Fundus photo. Centered on the macula — 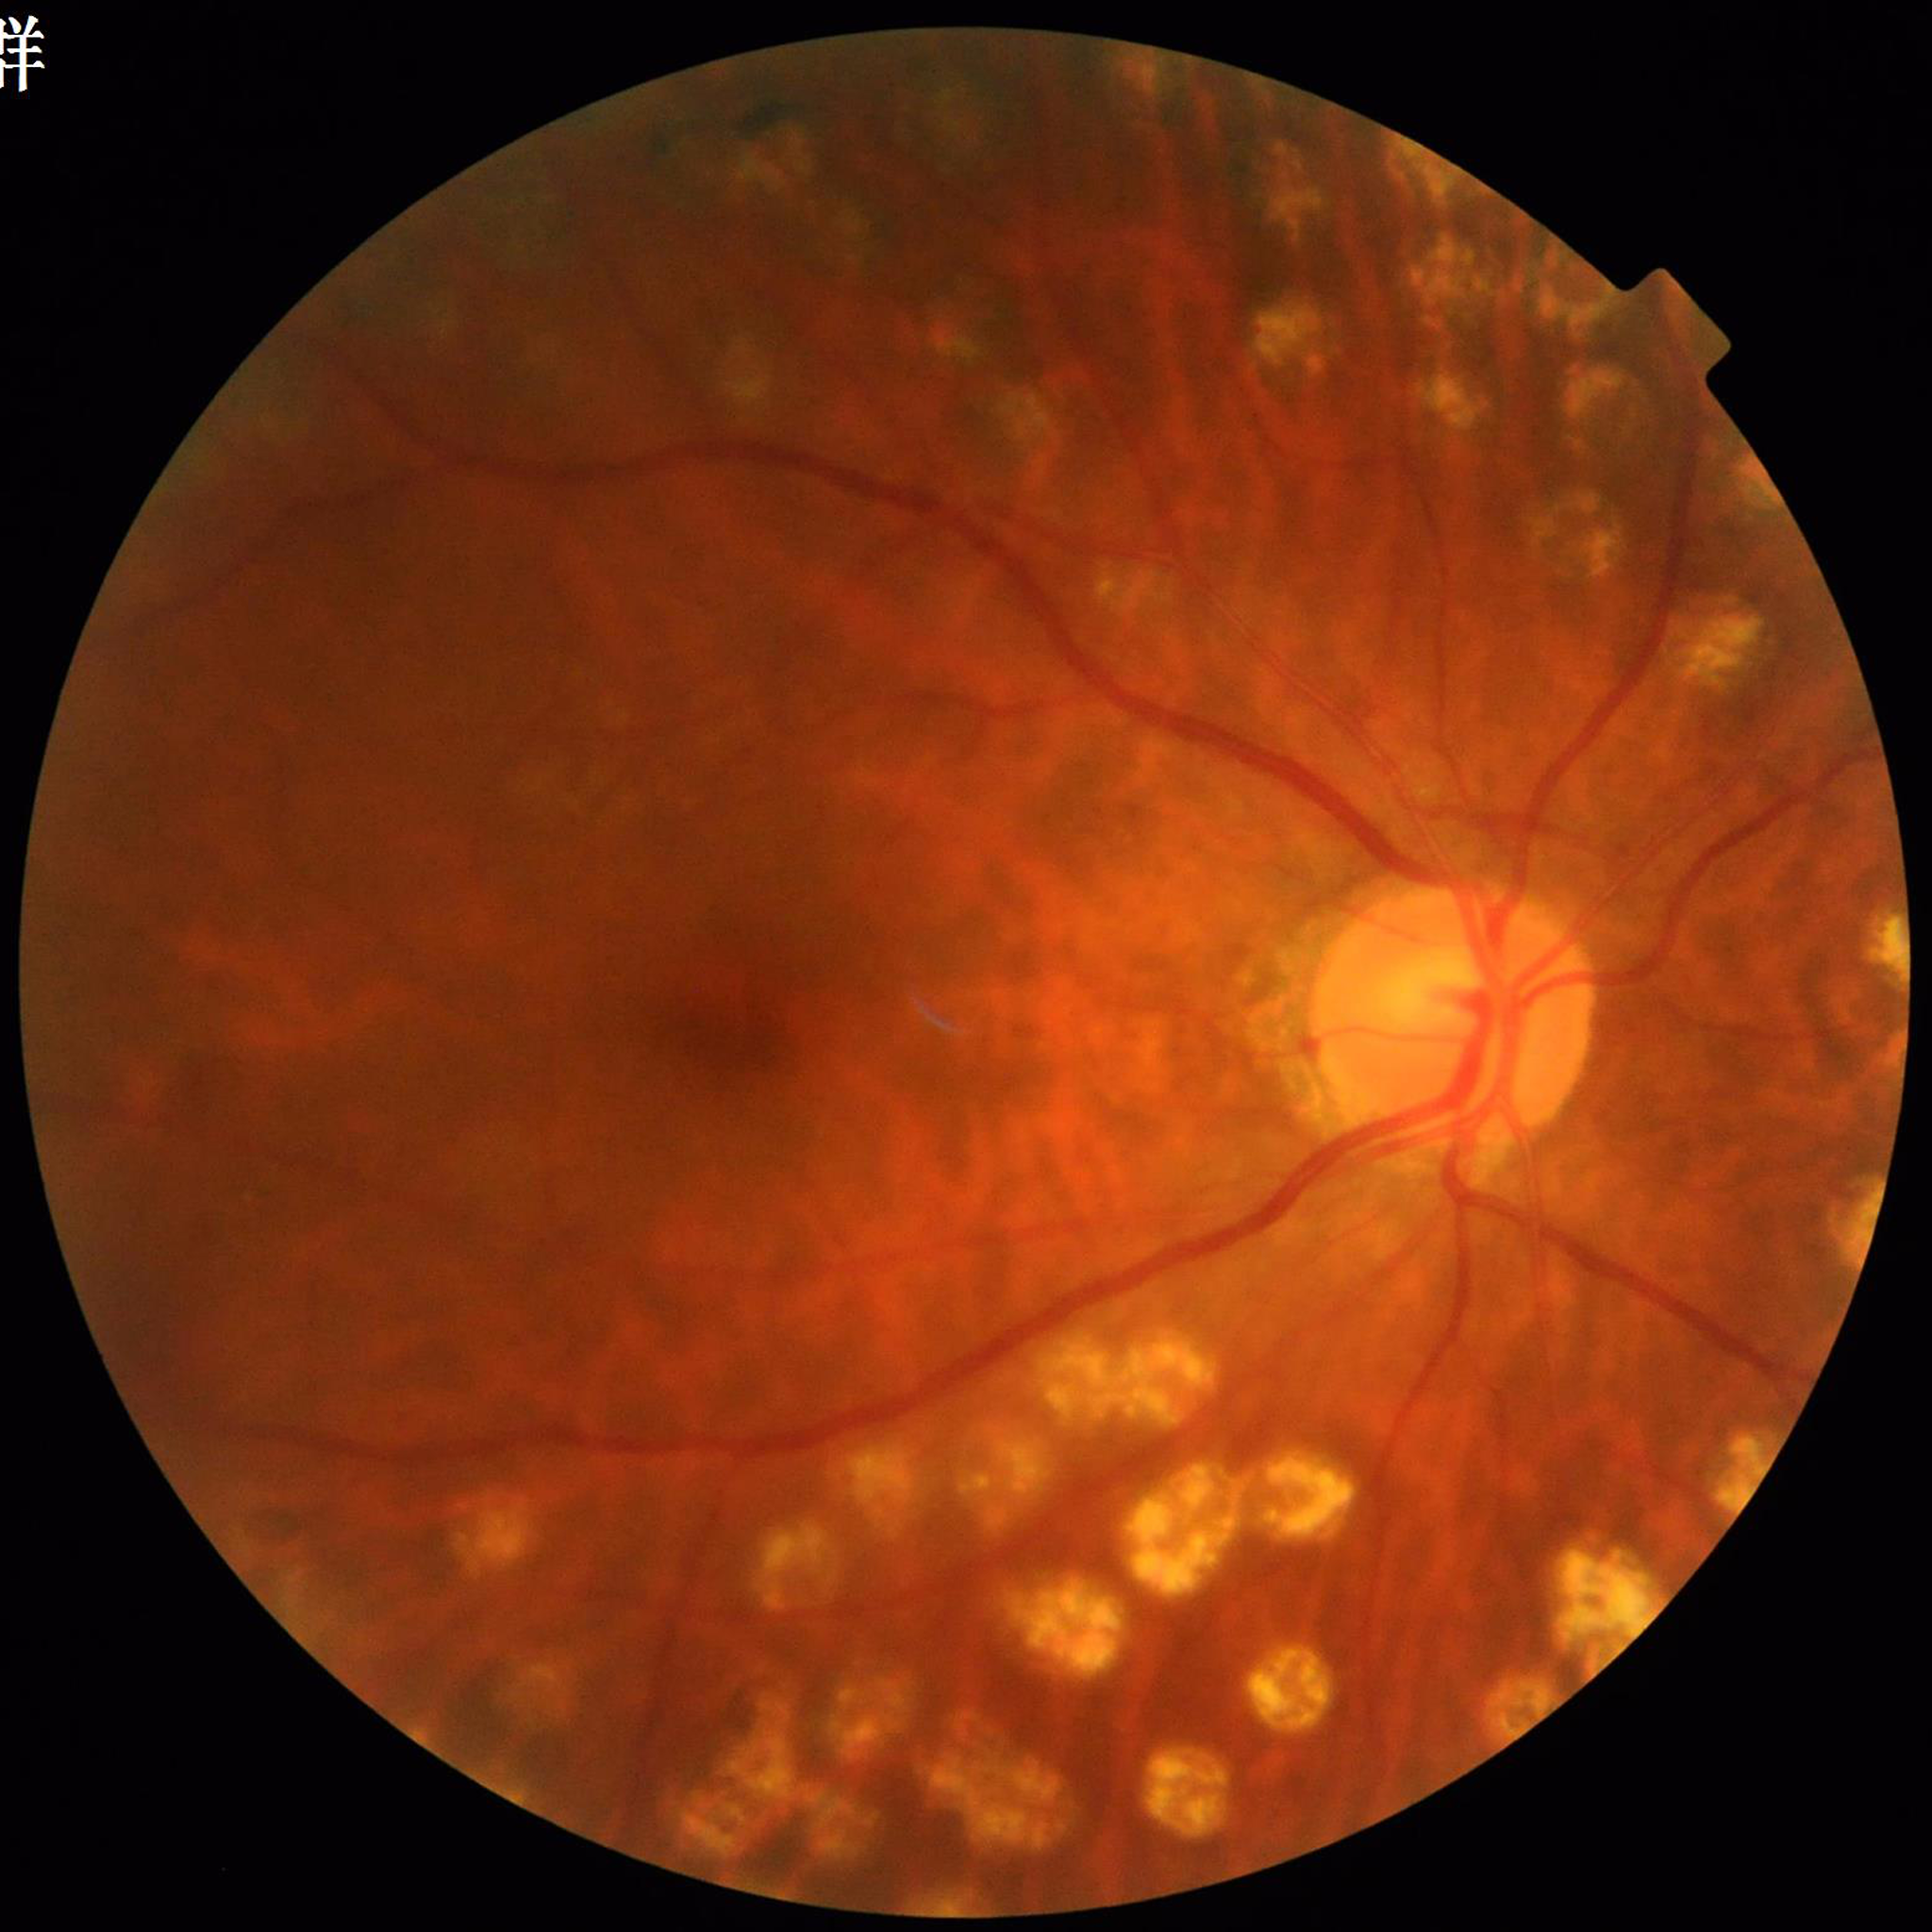

  image_quality: no concerns identified
  diagnosis: diabetic retinopathy